45-degree field of view — 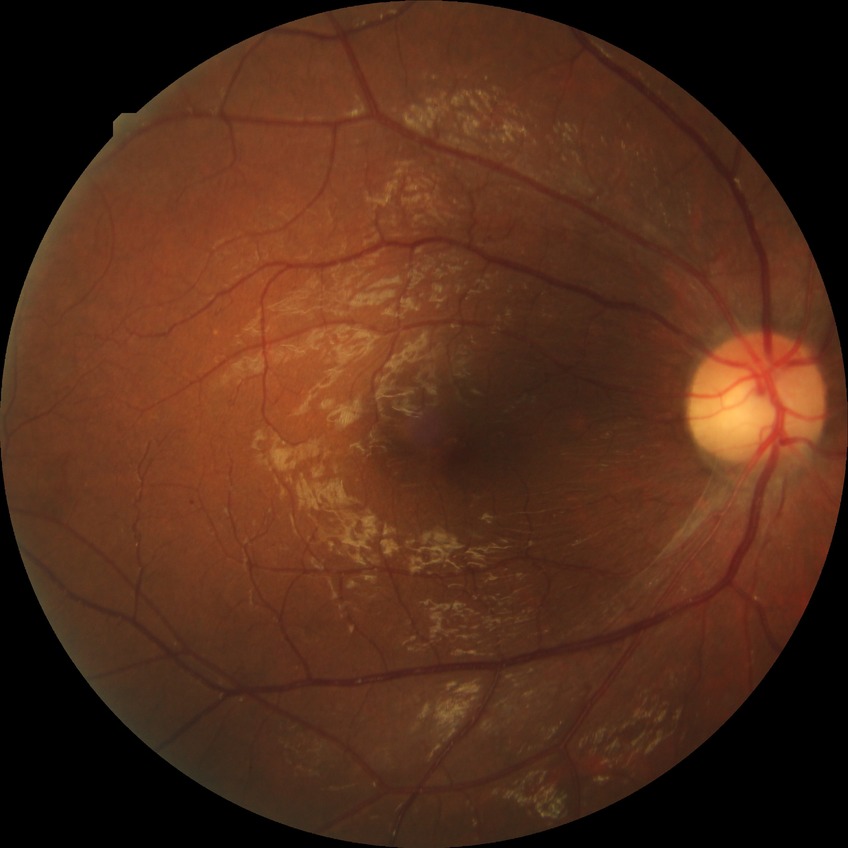

Modified Davis grading: proliferative diabetic retinopathy.